Image size 2352x1568.
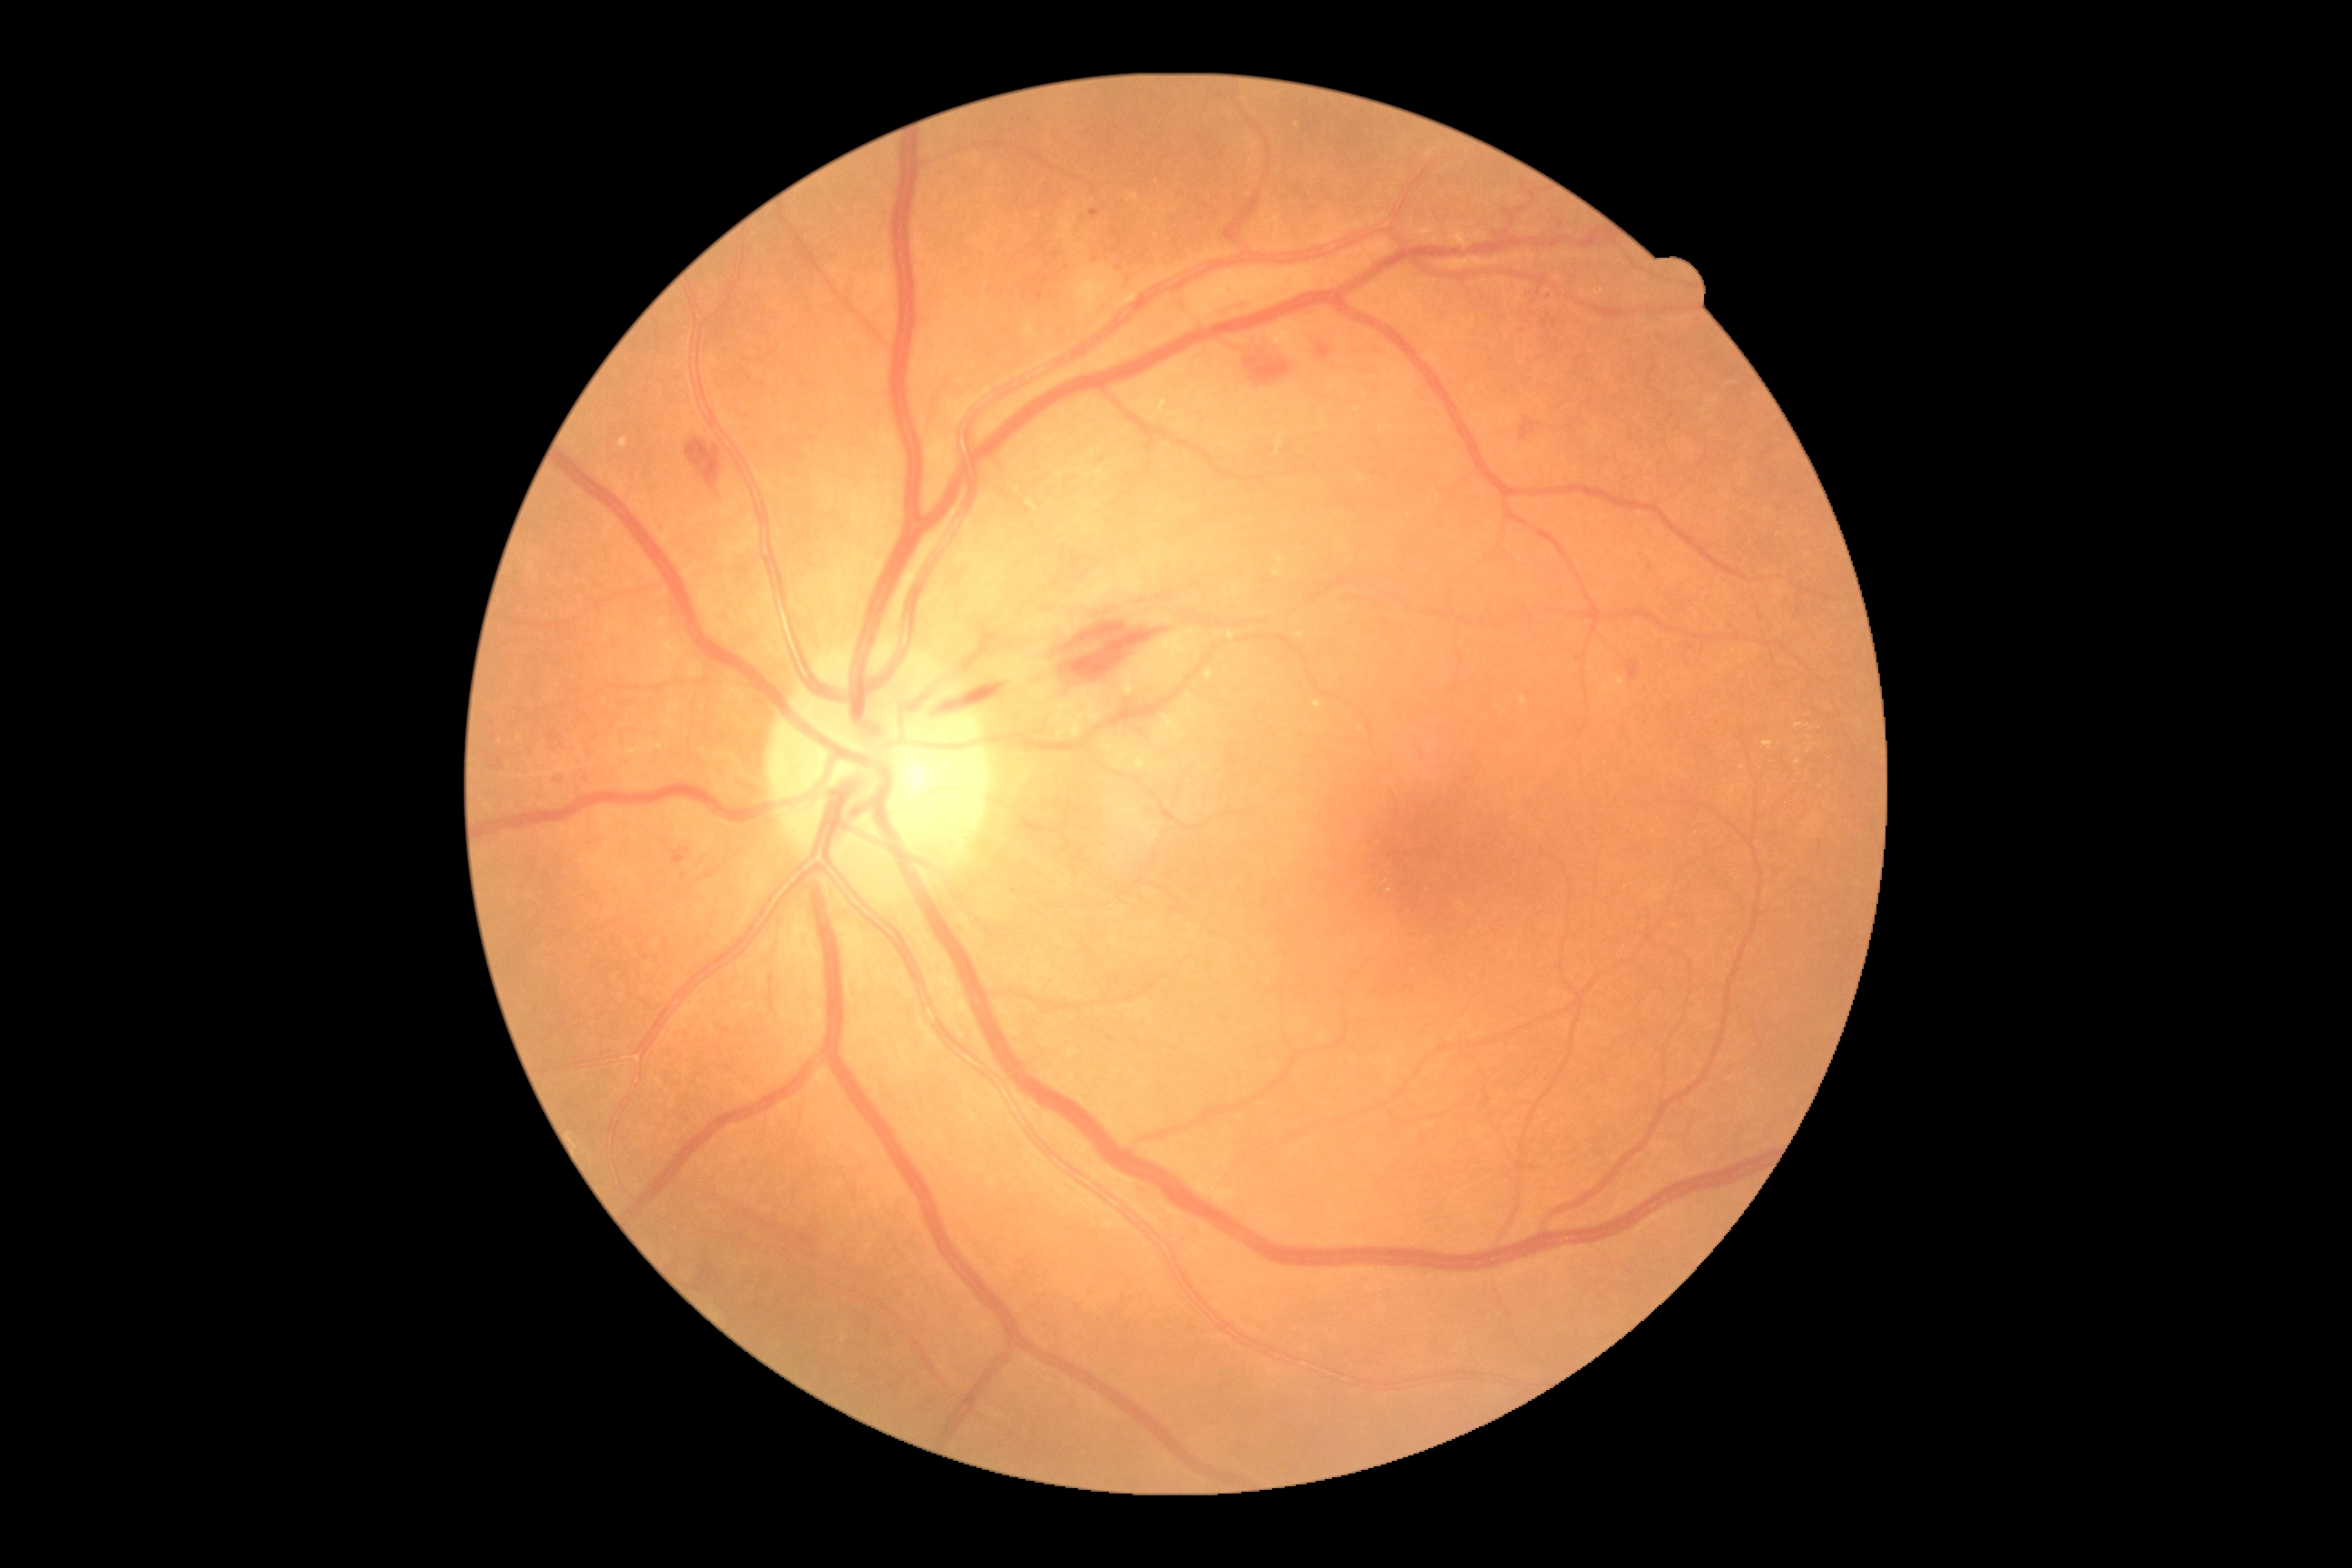

DR grade: 2.